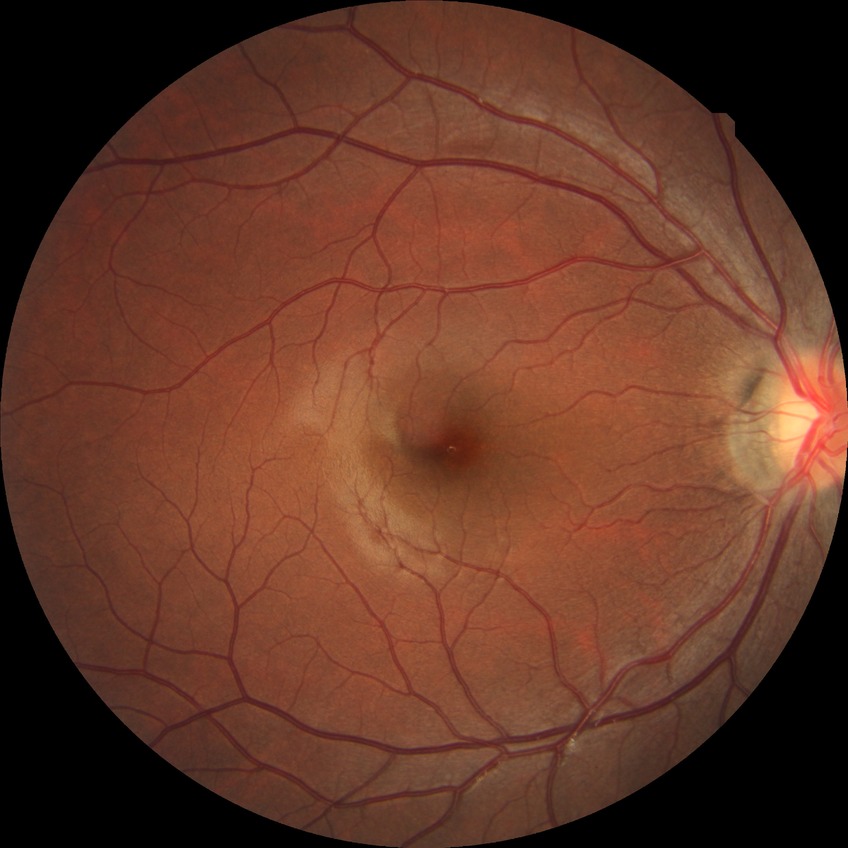 diabetic retinopathy stage: no diabetic retinopathy.